Fundus photo · 45° field of view
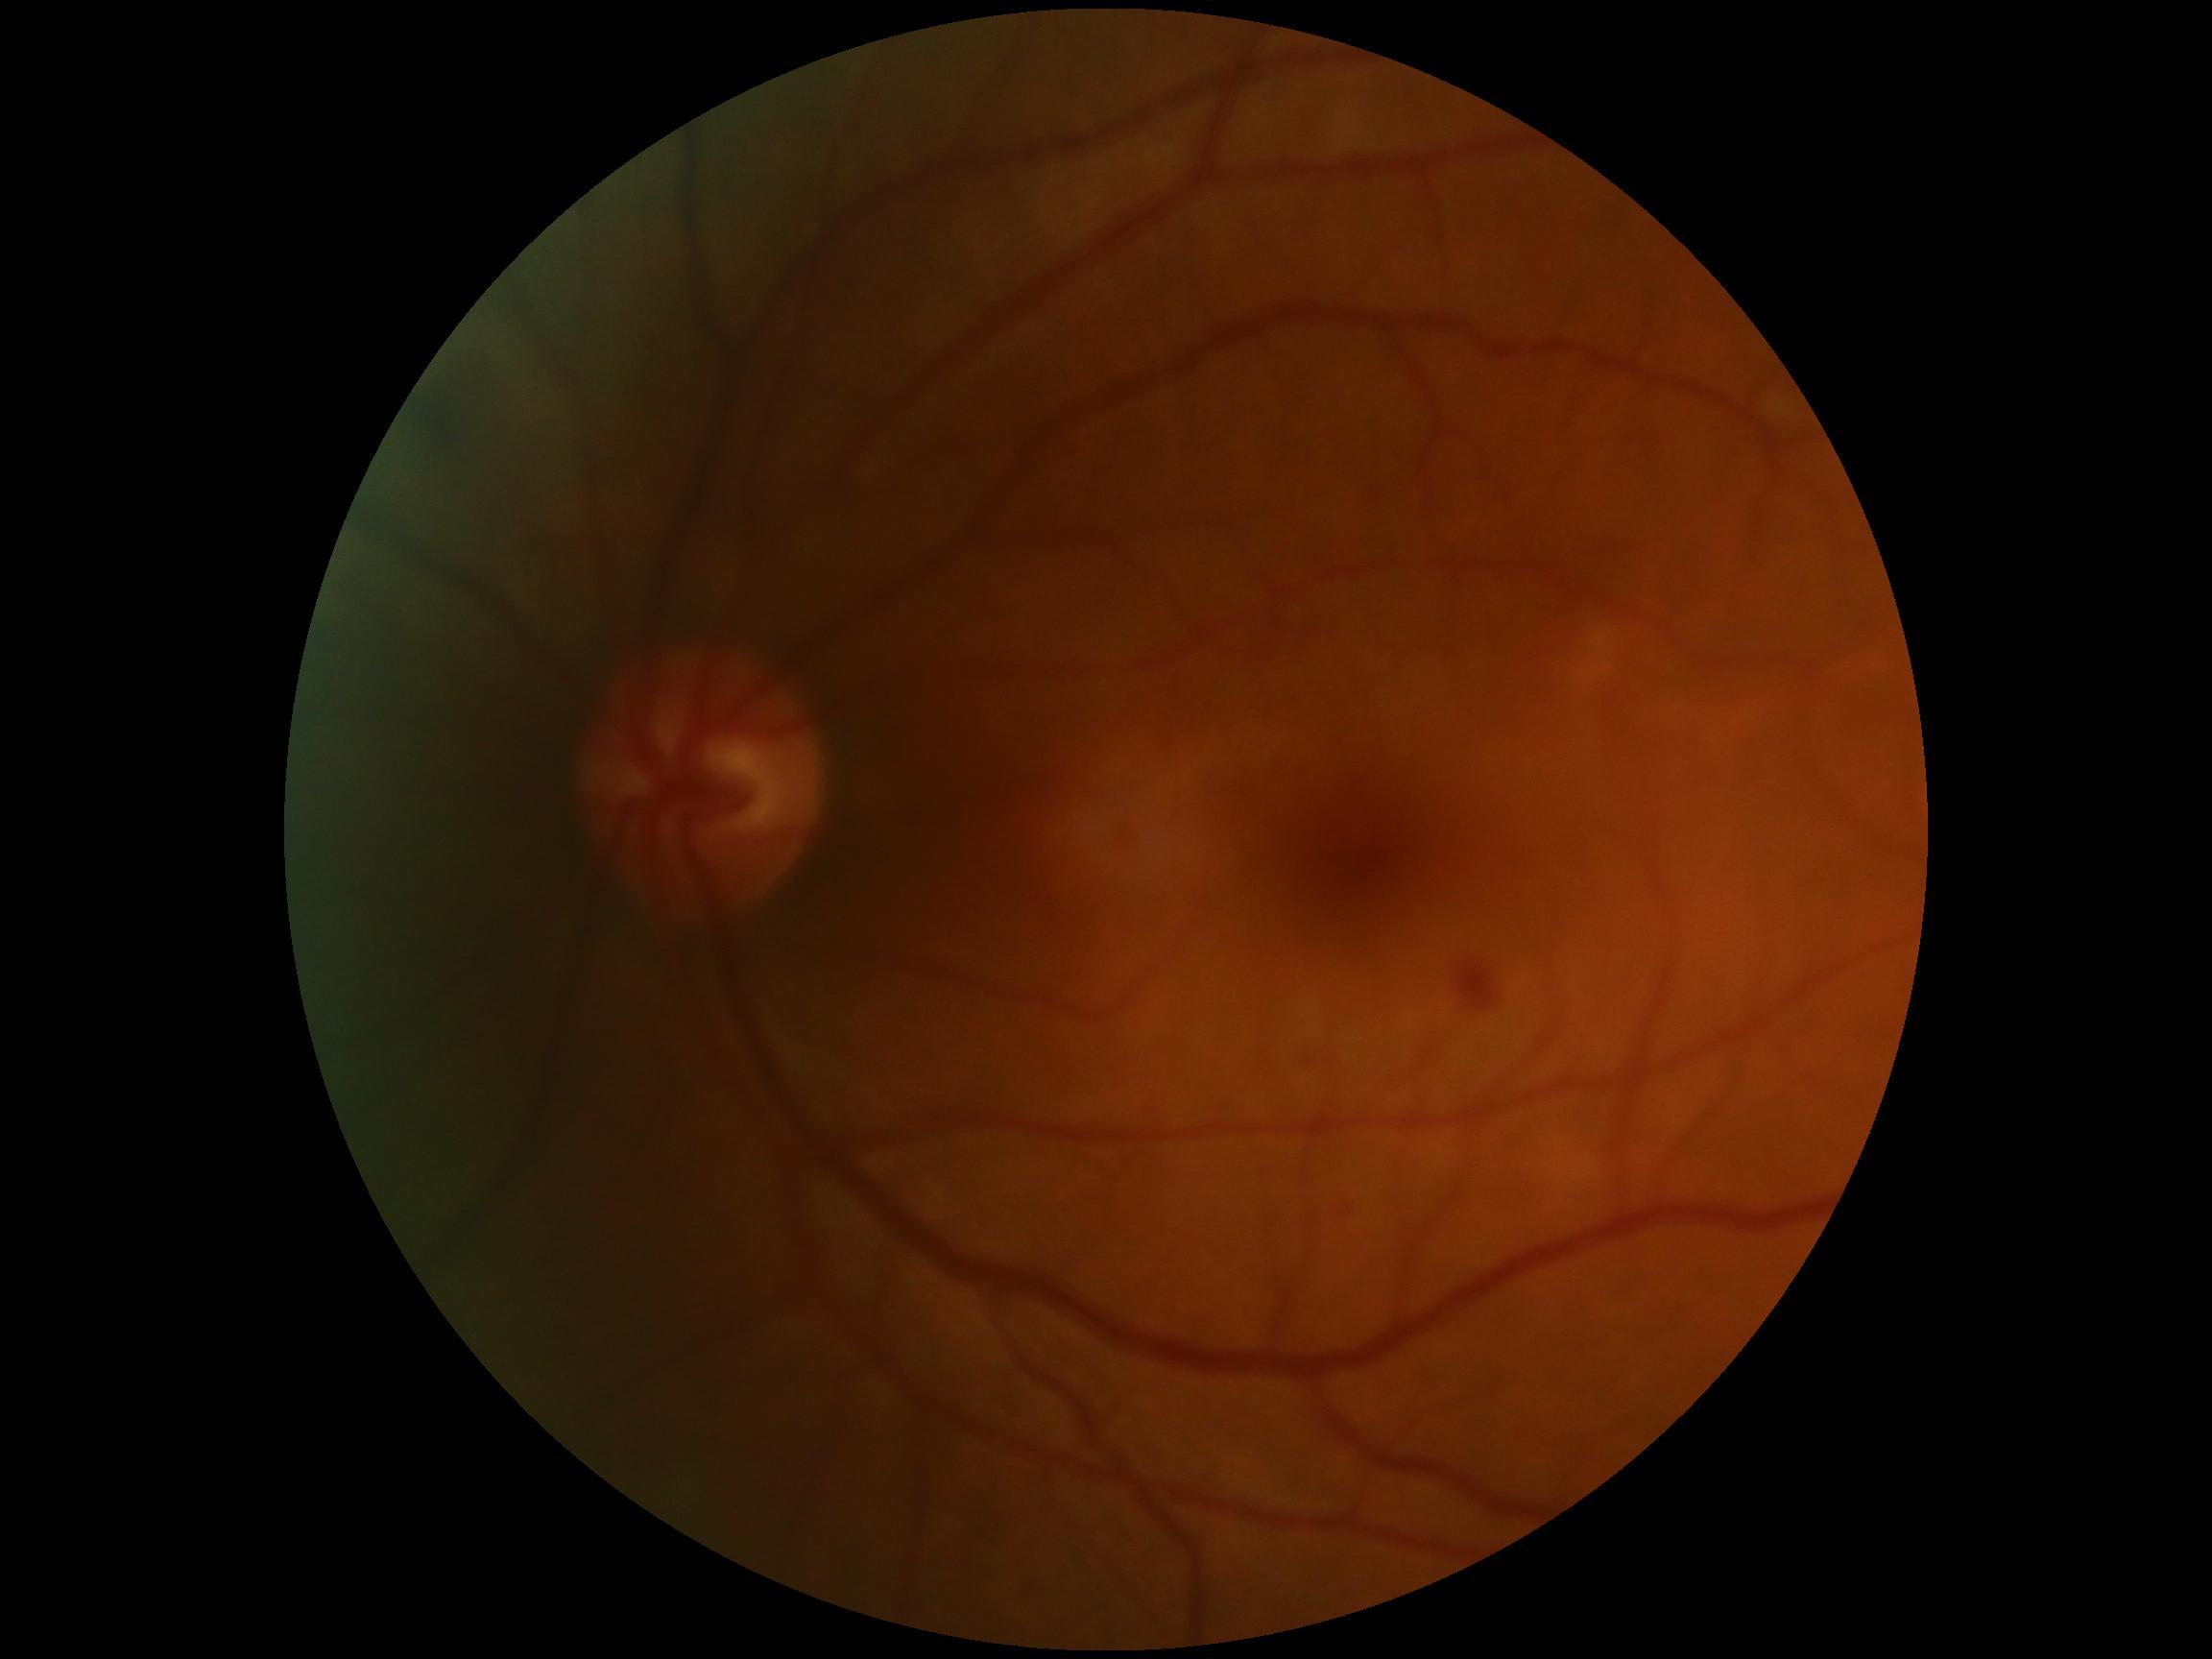 DR severity is 2.